Camera: Natus RetCam Envision (130° FOV). Wide-field fundus photograph of an infant. 1440x1080
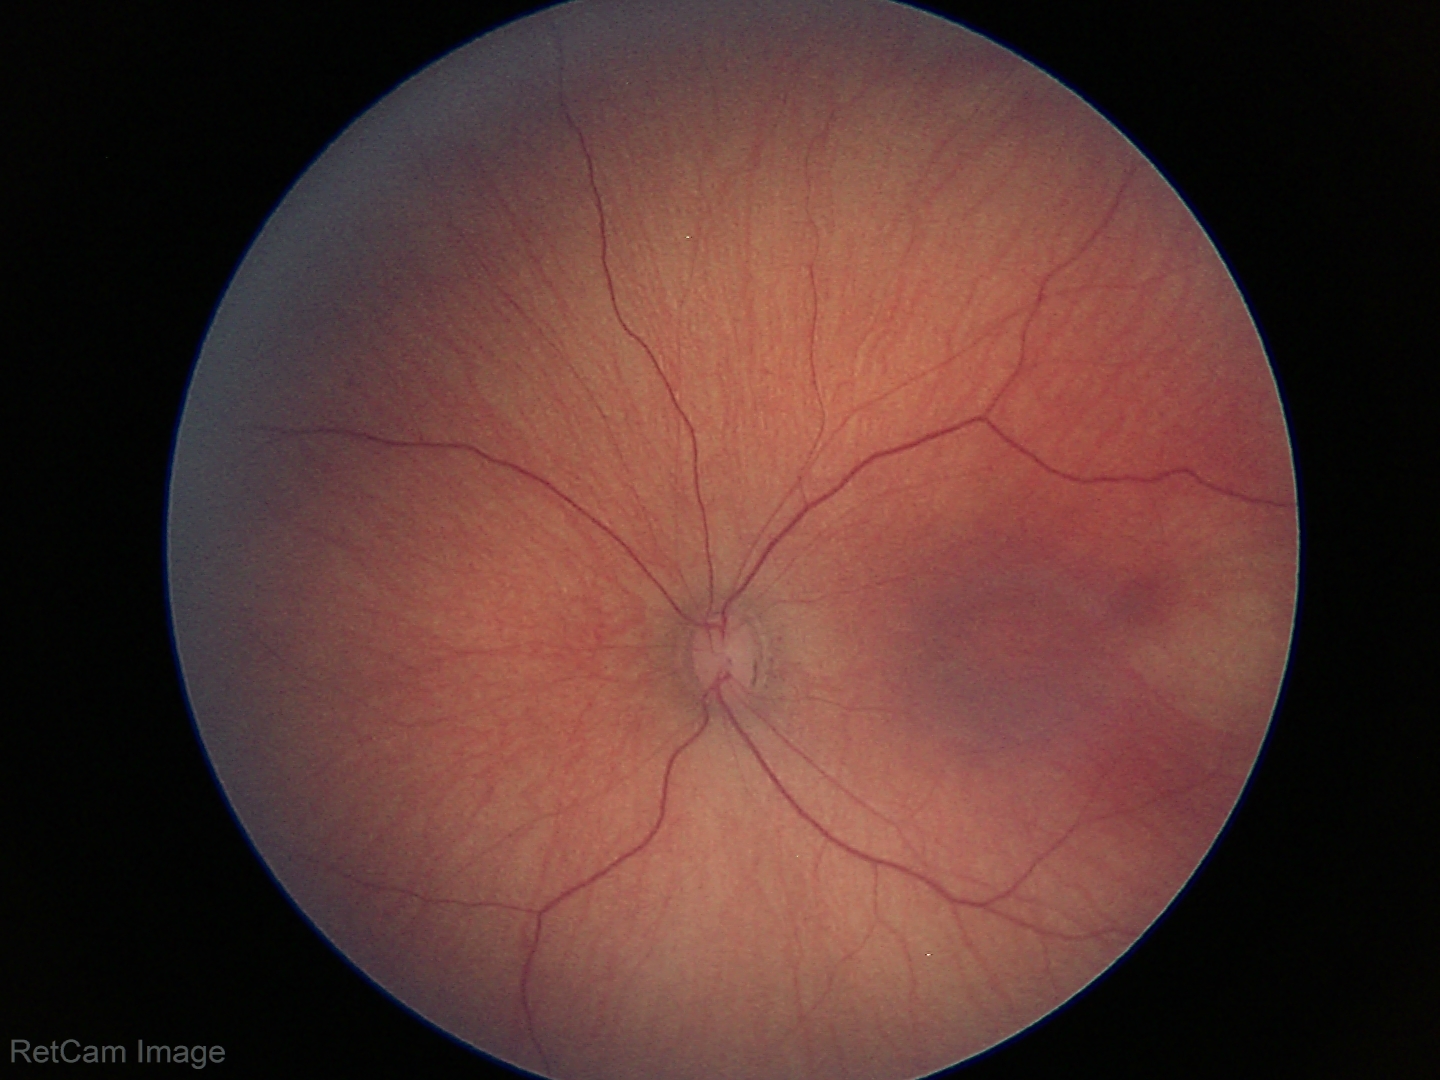

Diagnosis = physiological appearance.